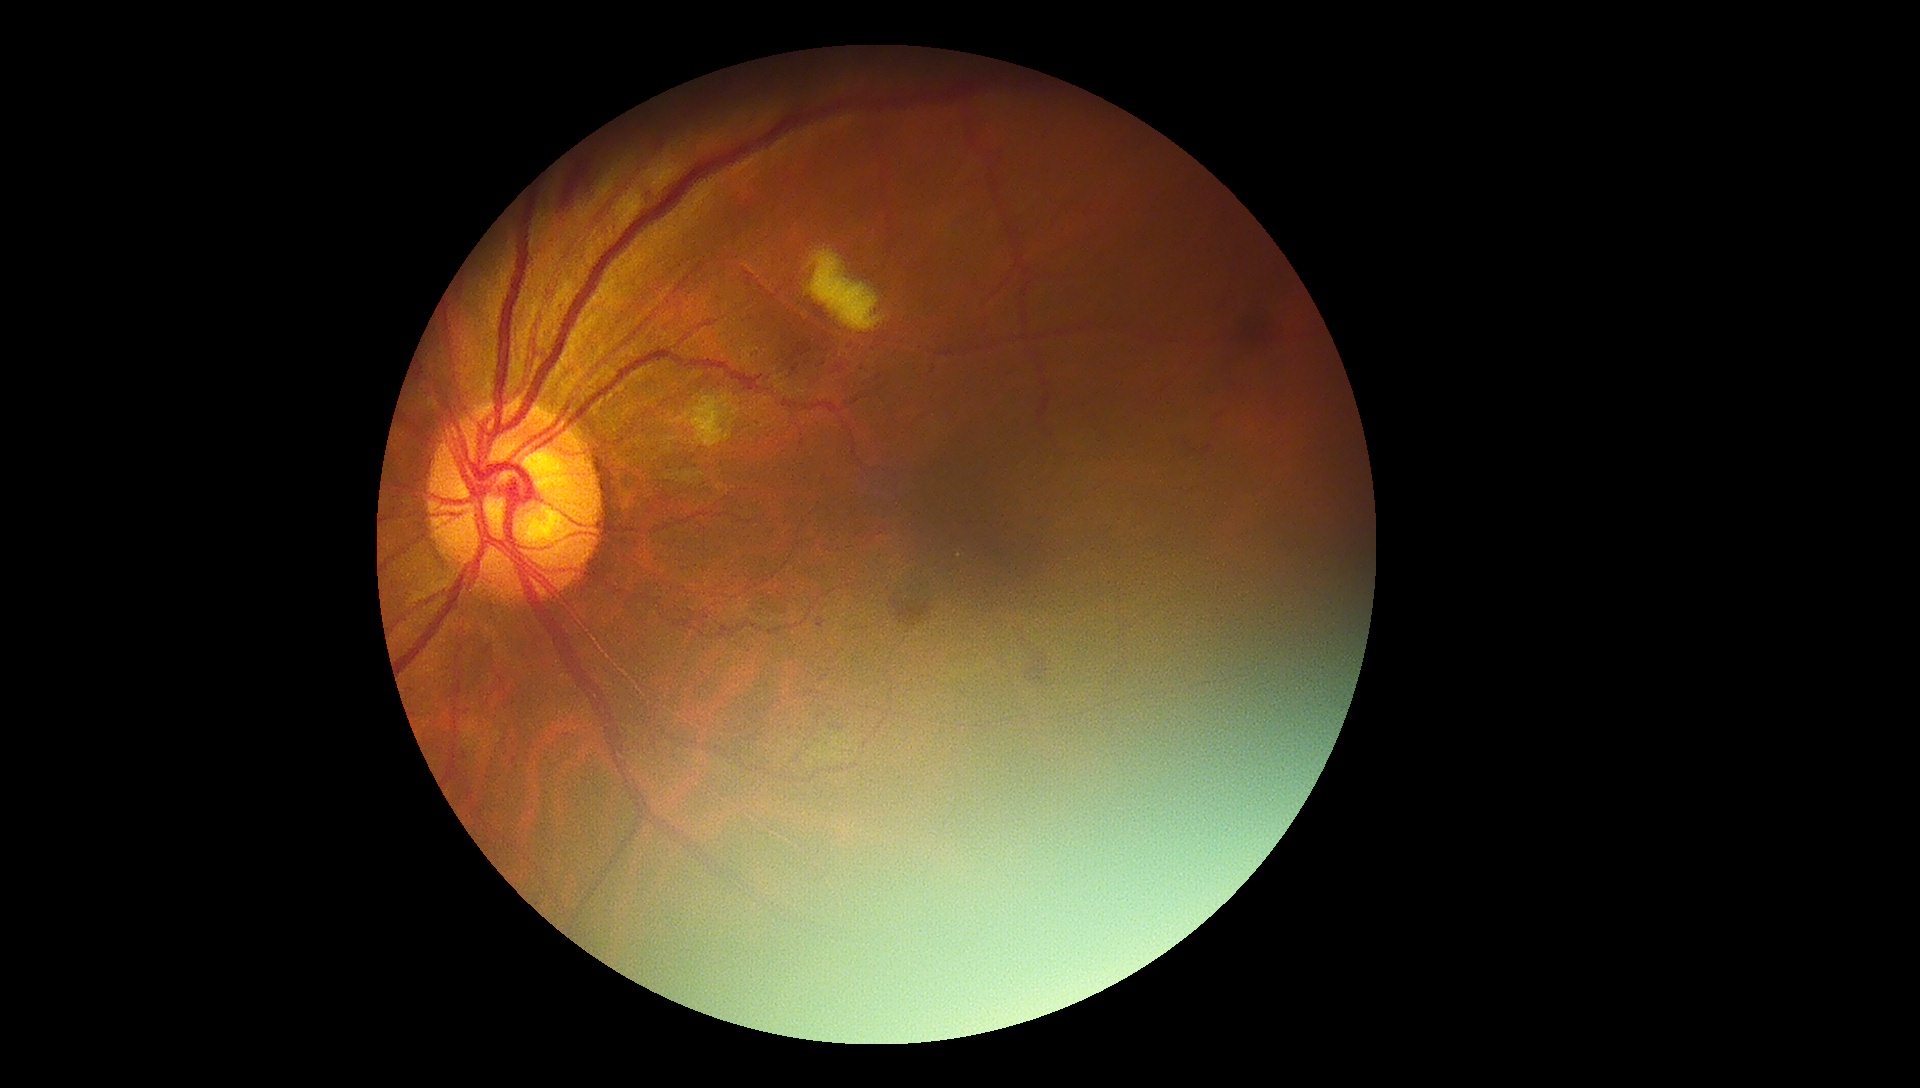

diabetic retinopathy severity: 2/4